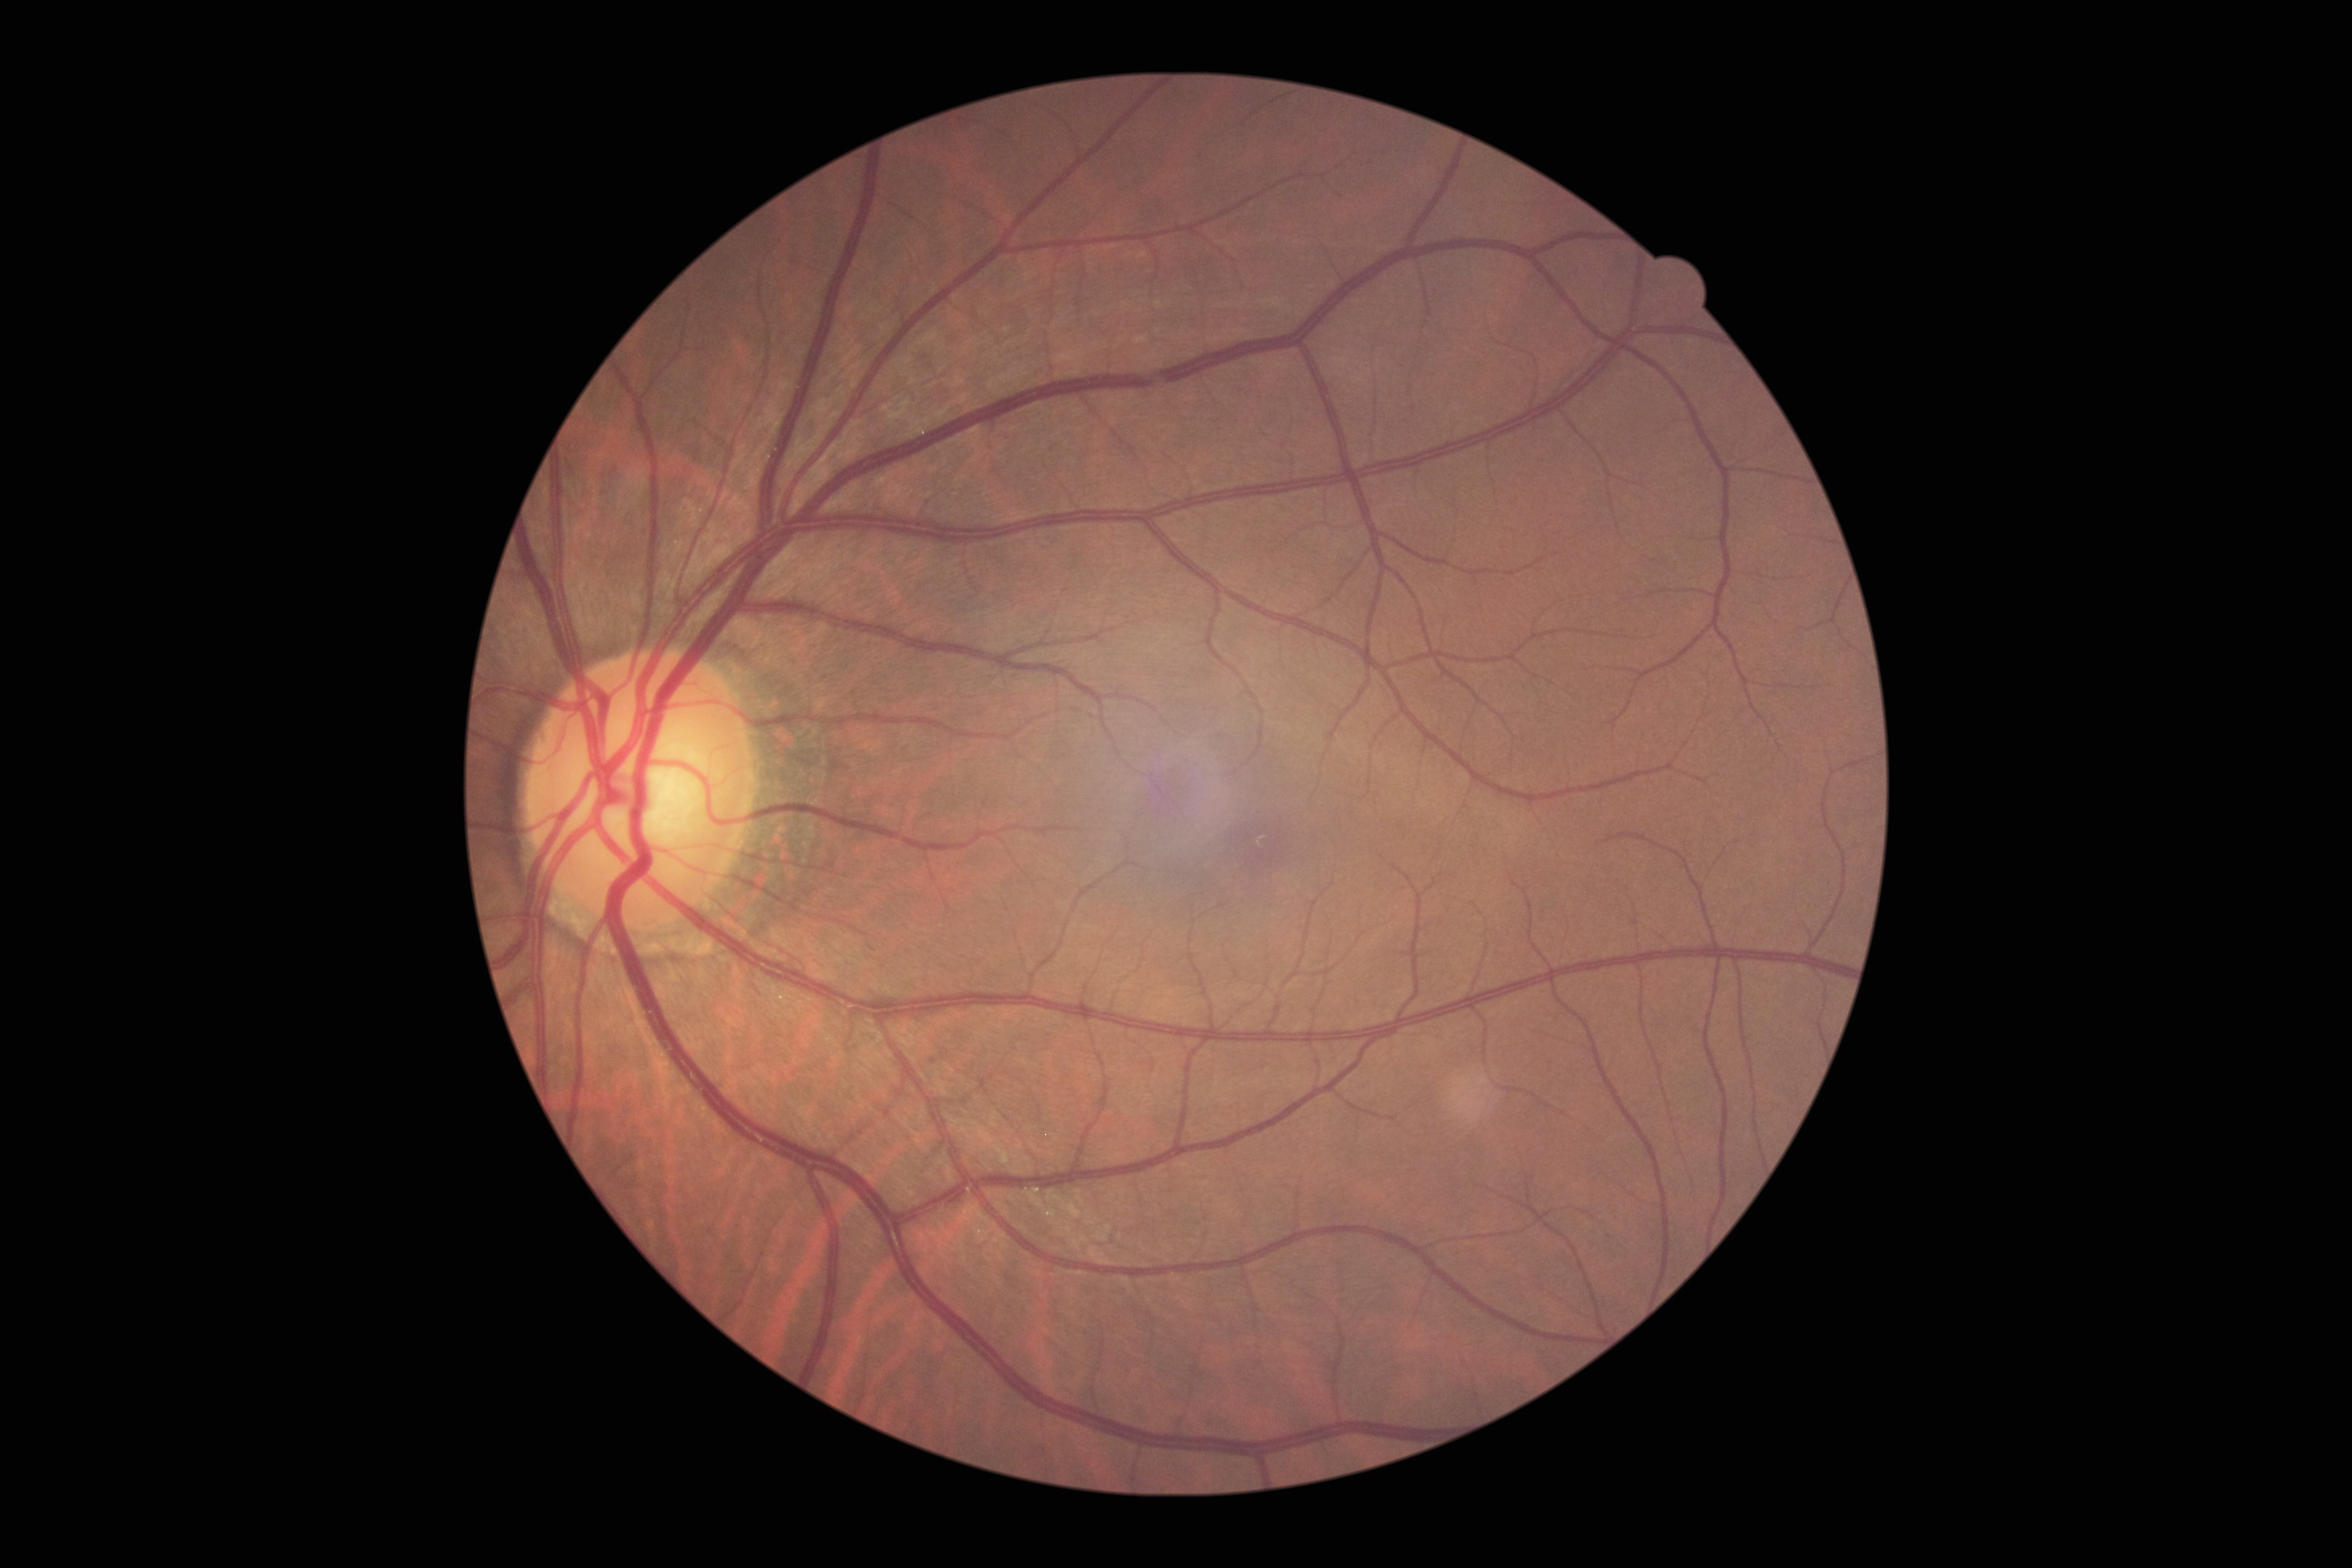 Diabetic retinopathy grade: 1.